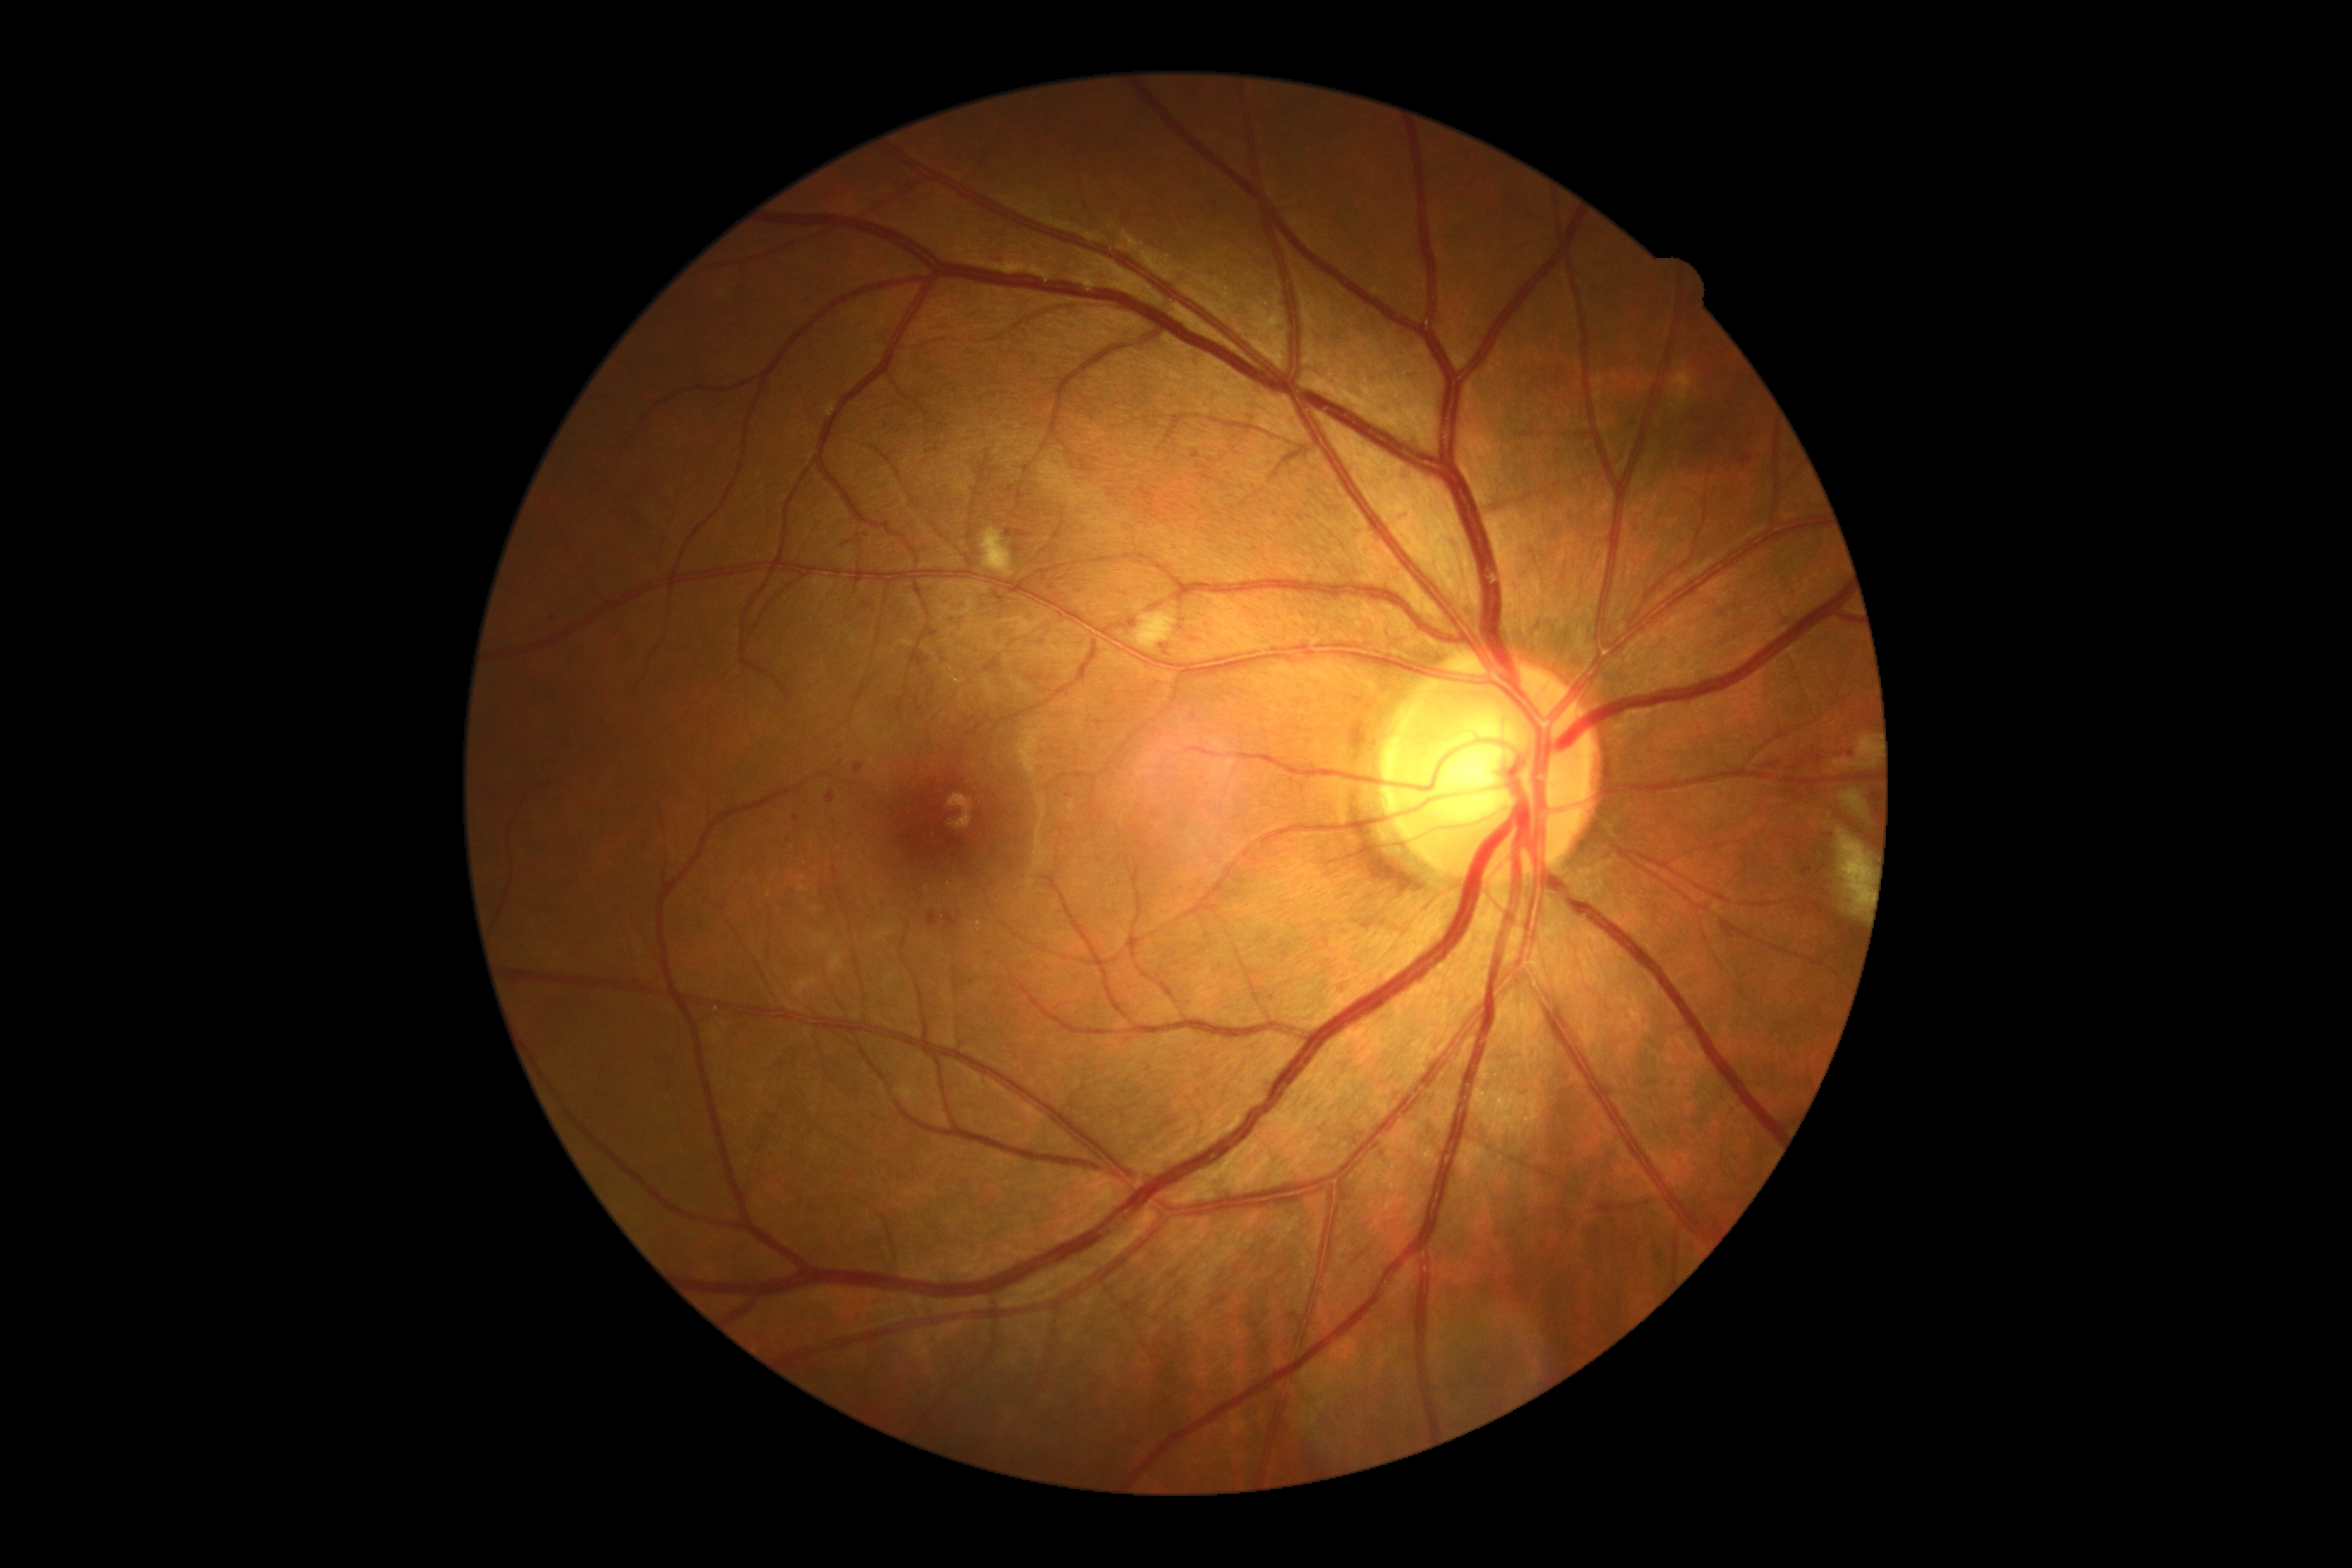 Retinopathy grade: moderate non-proliferative diabetic retinopathy (2).